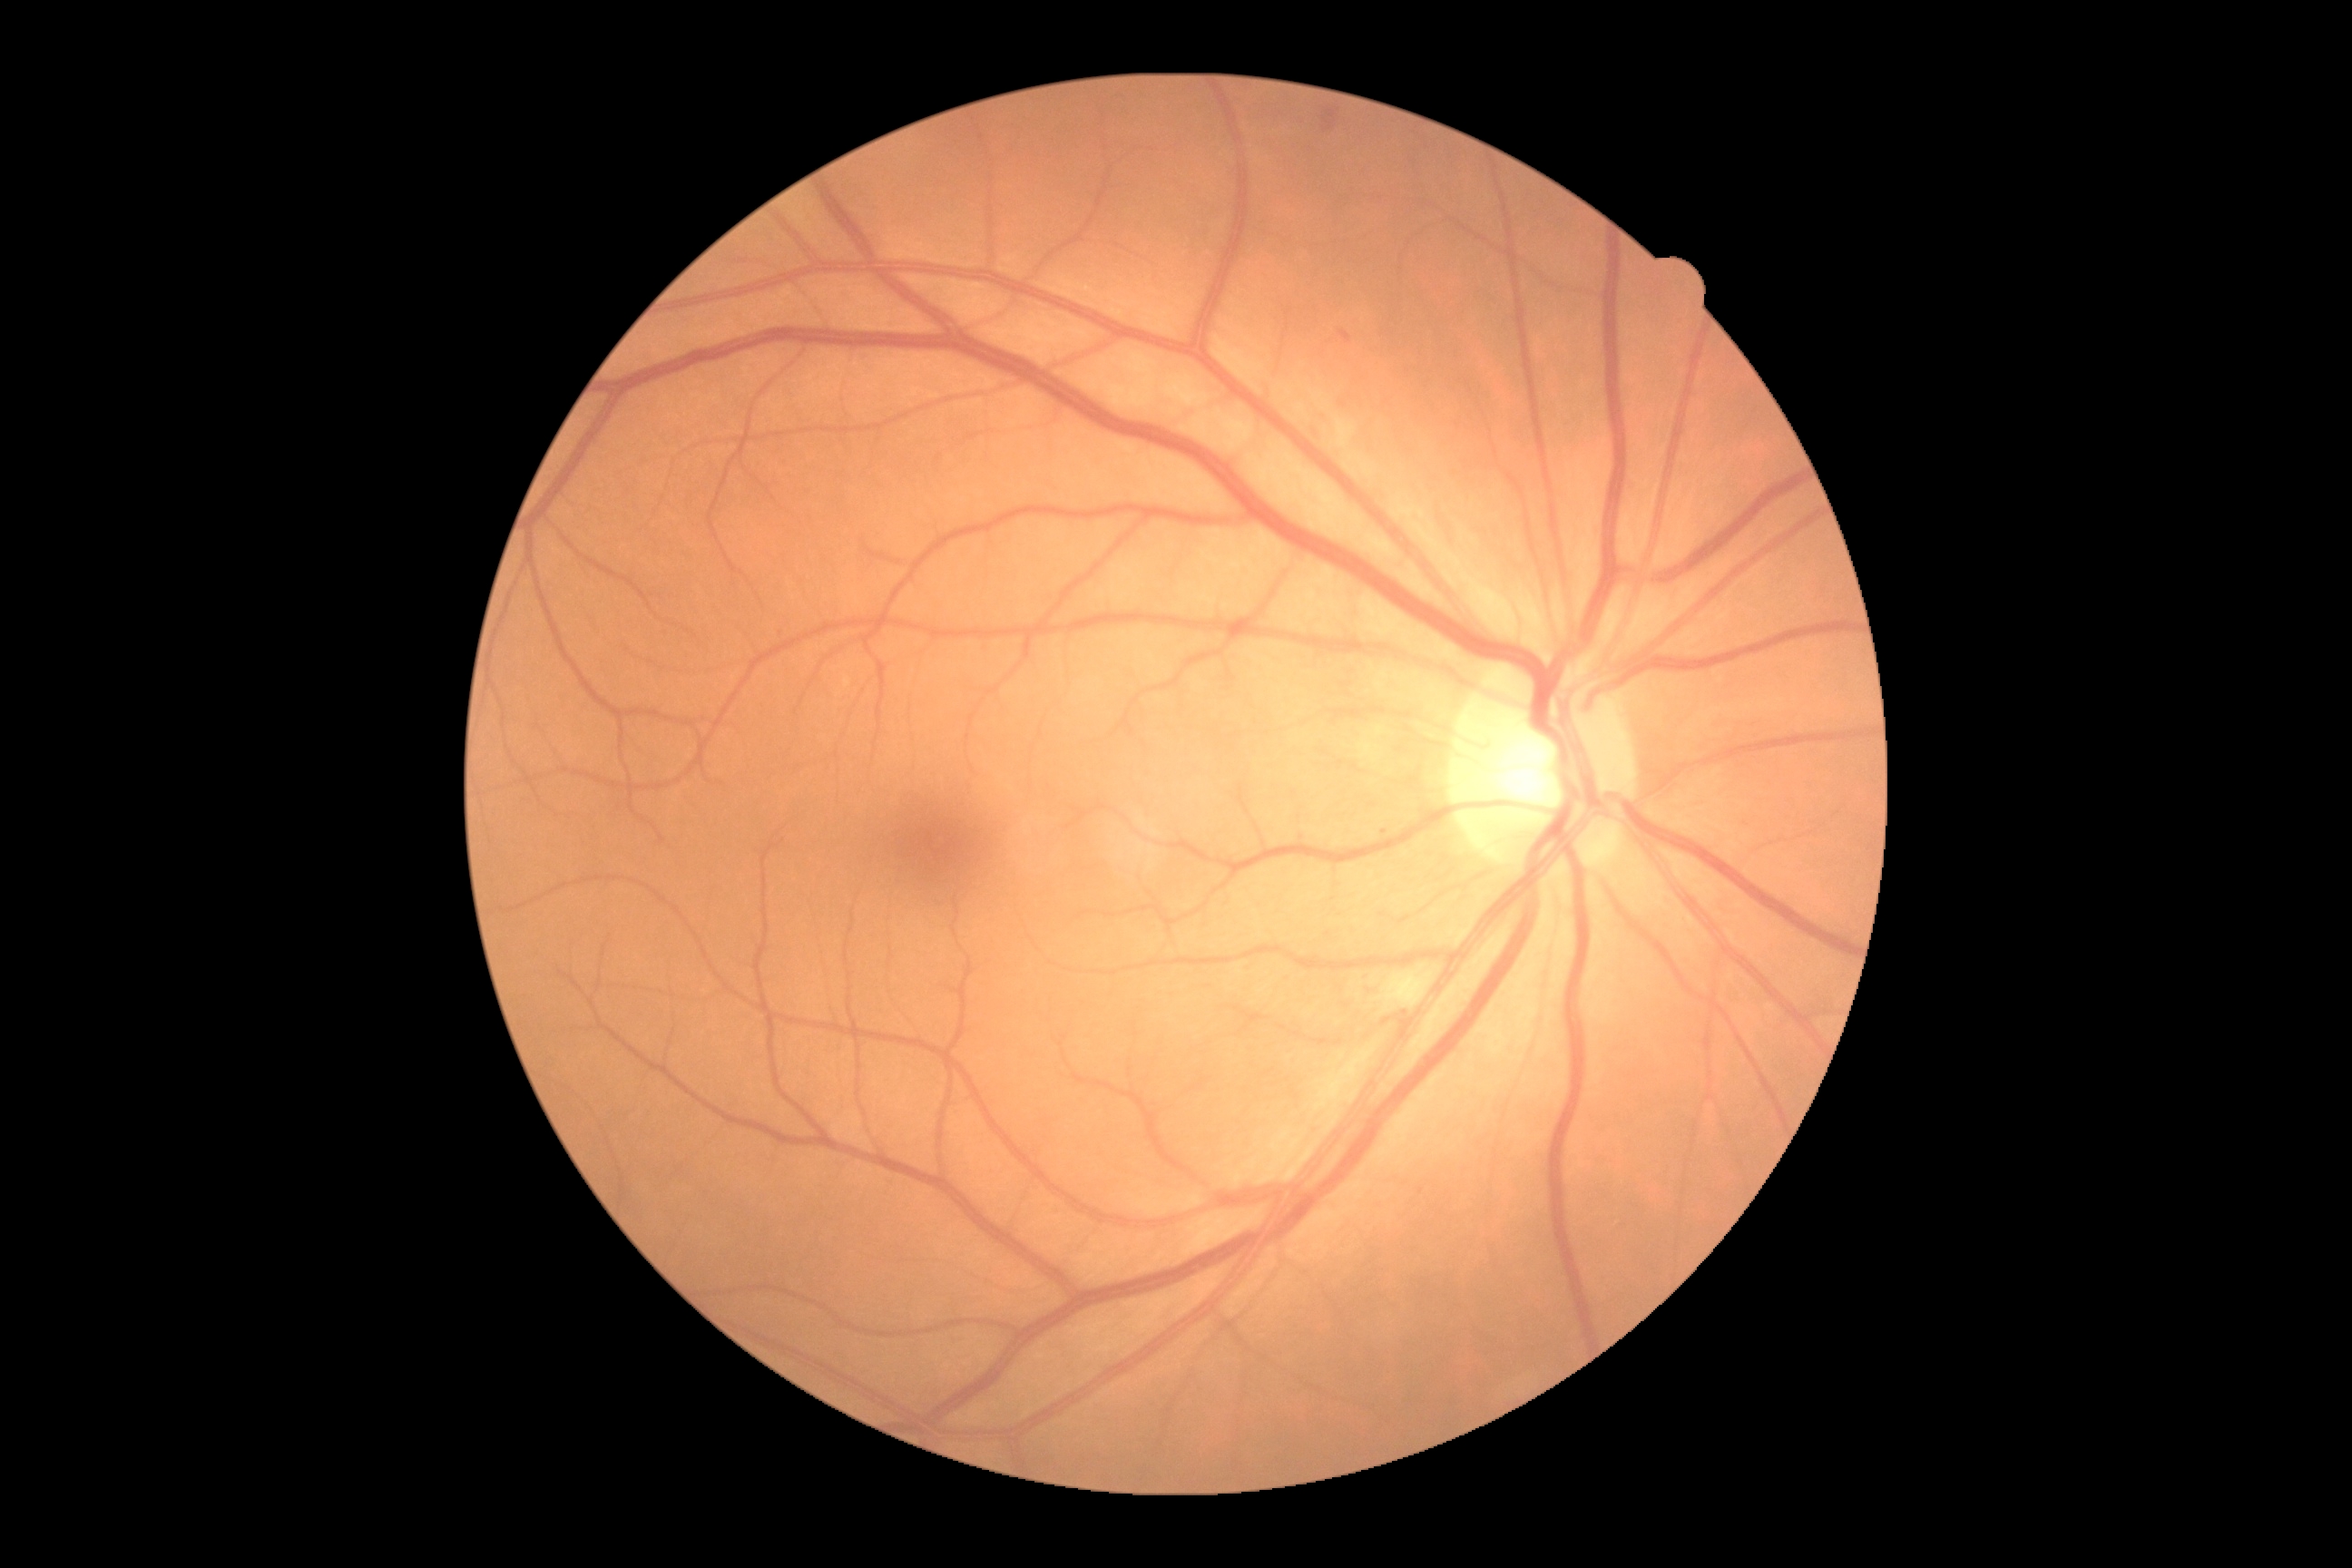

Diabetic retinopathy grade: 2 — more than just microaneurysms but less than severe NPDR.